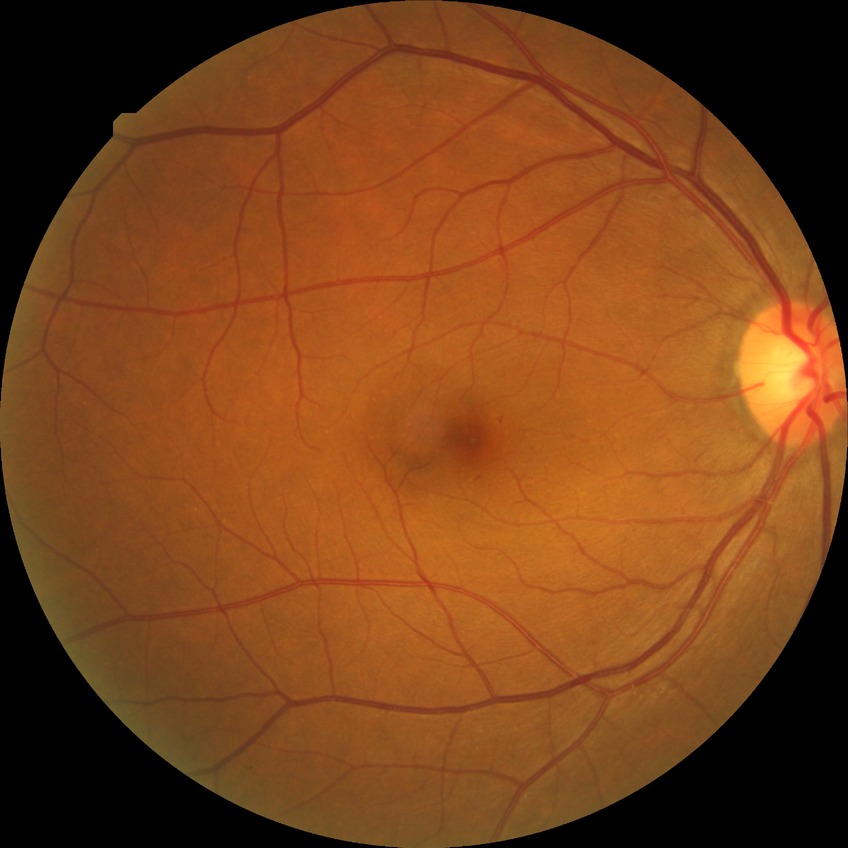
Davis grade: SDR.